Non-mydriatic; disc-centered field
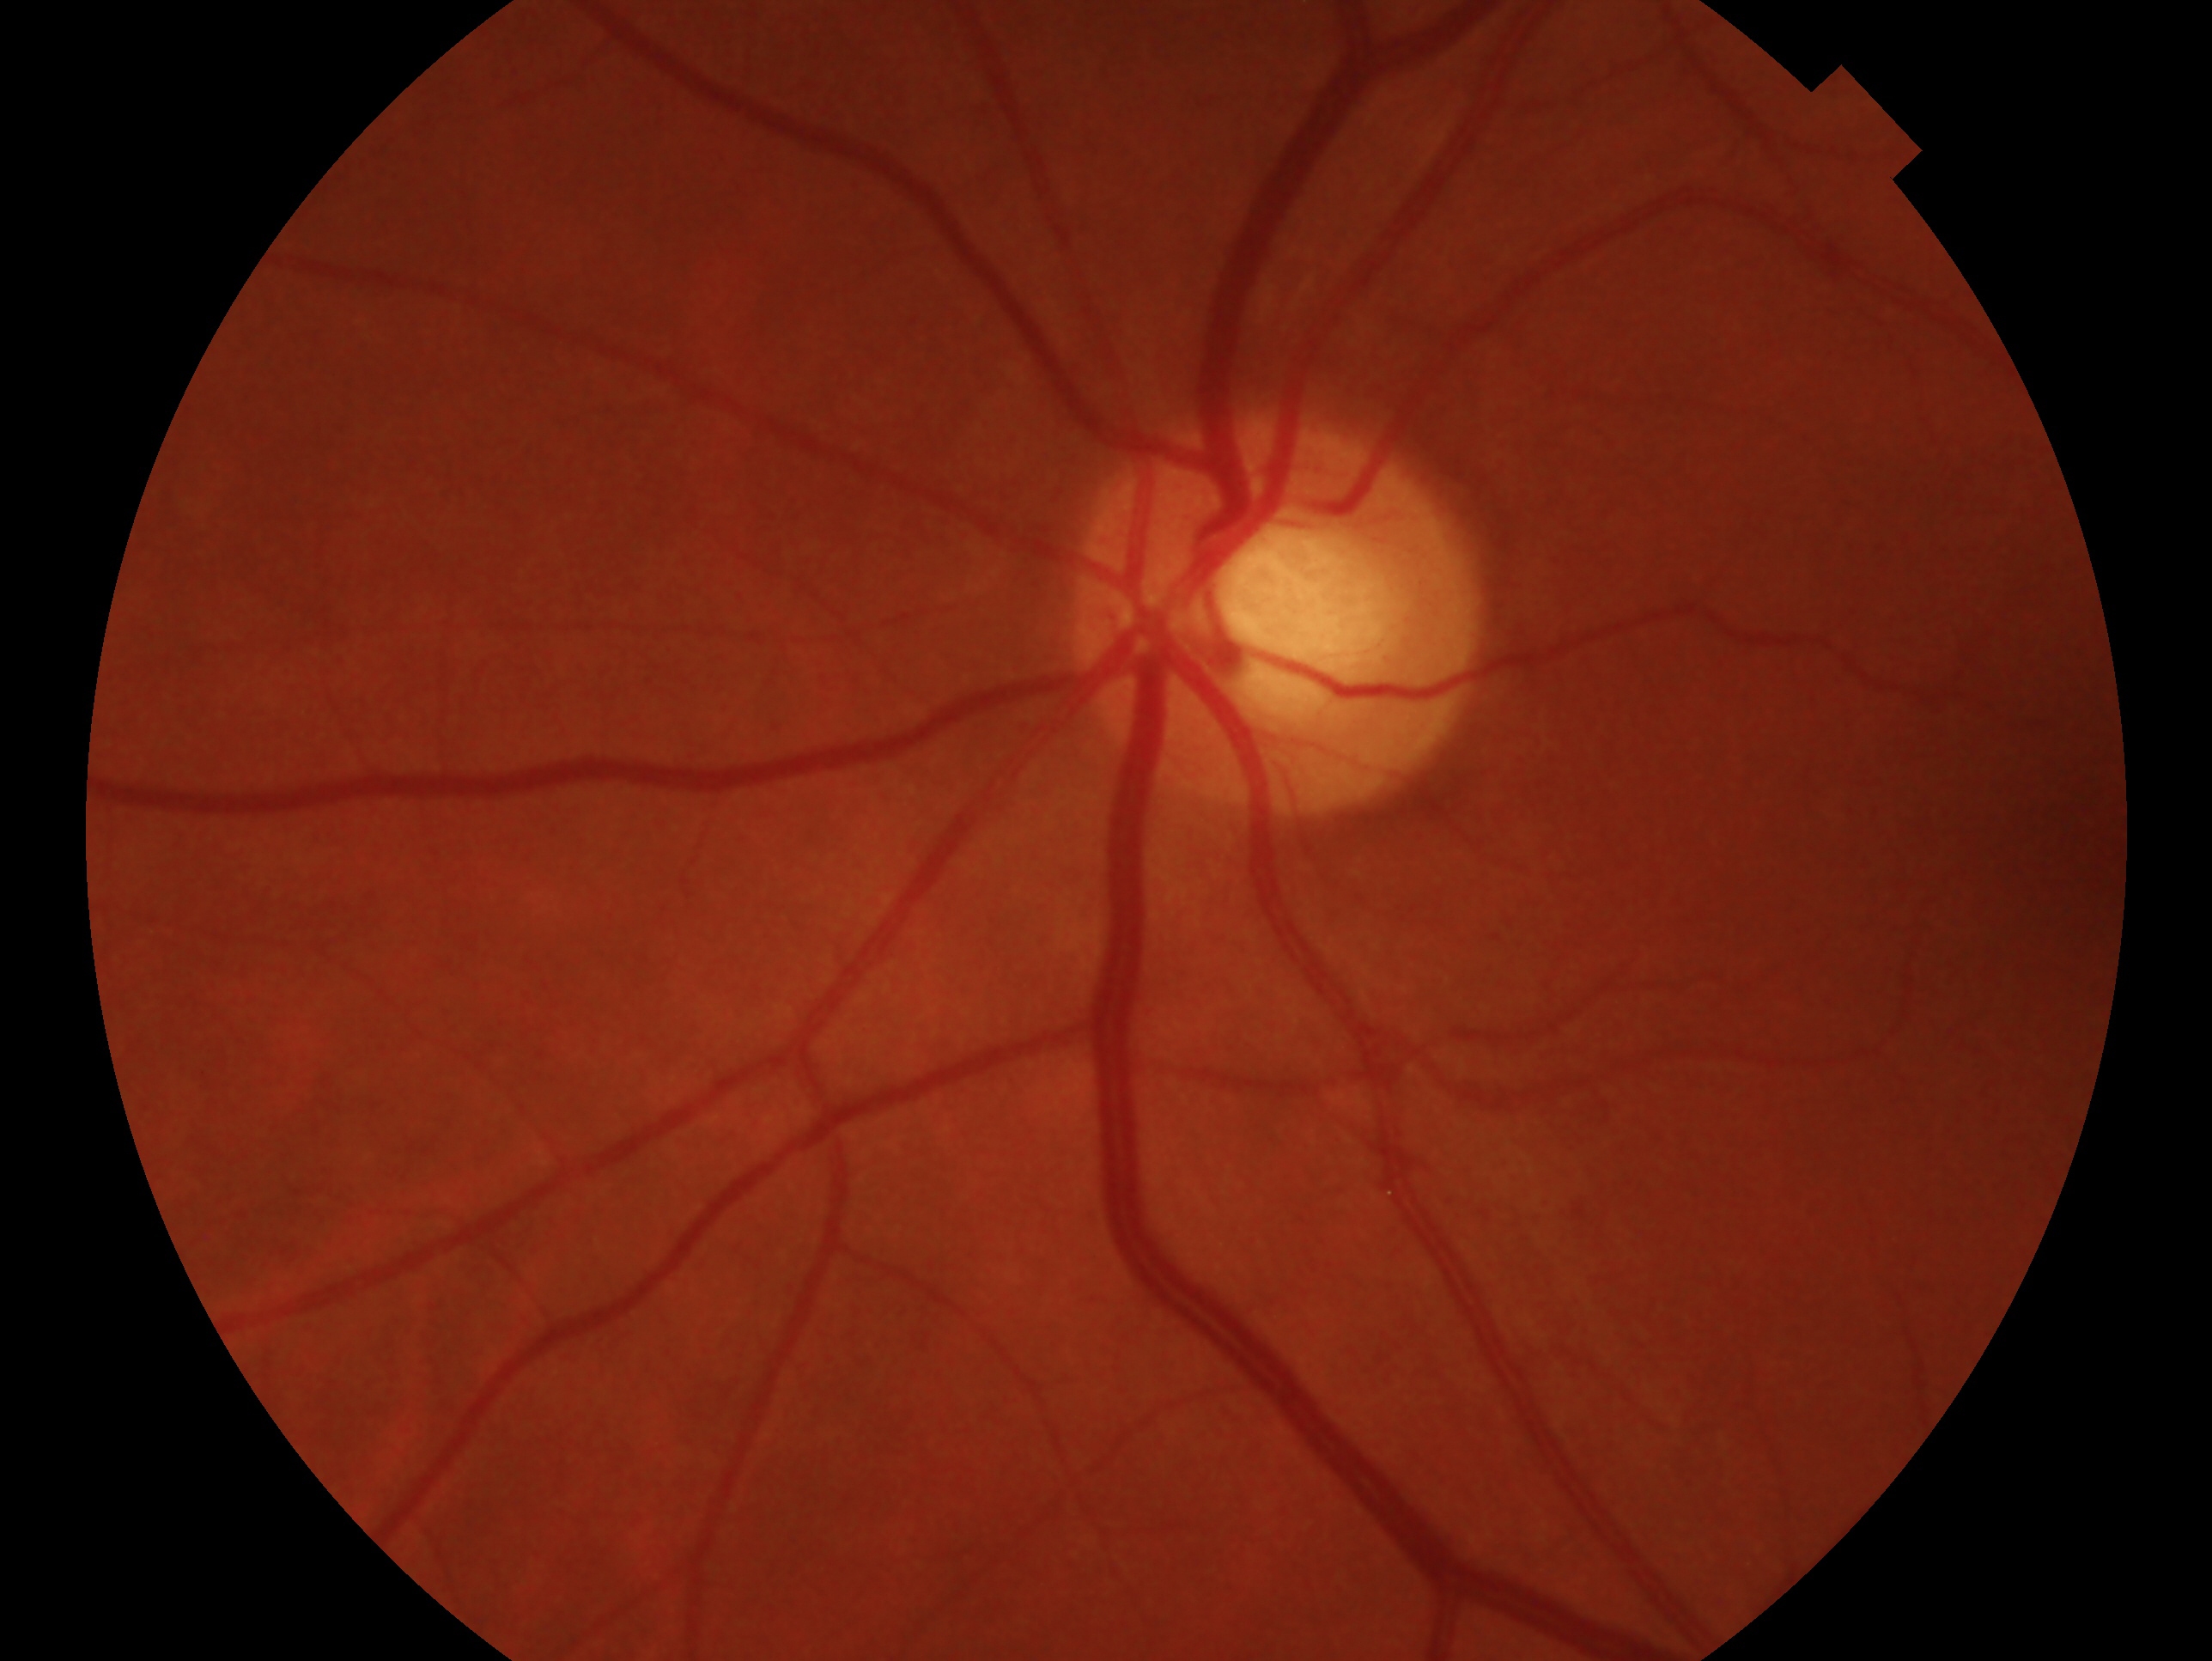 Findings:
- clinical classification · suspected glaucoma
- laterality · oculus sinister